Color fundus image, NIDEK AFC-230 fundus camera.
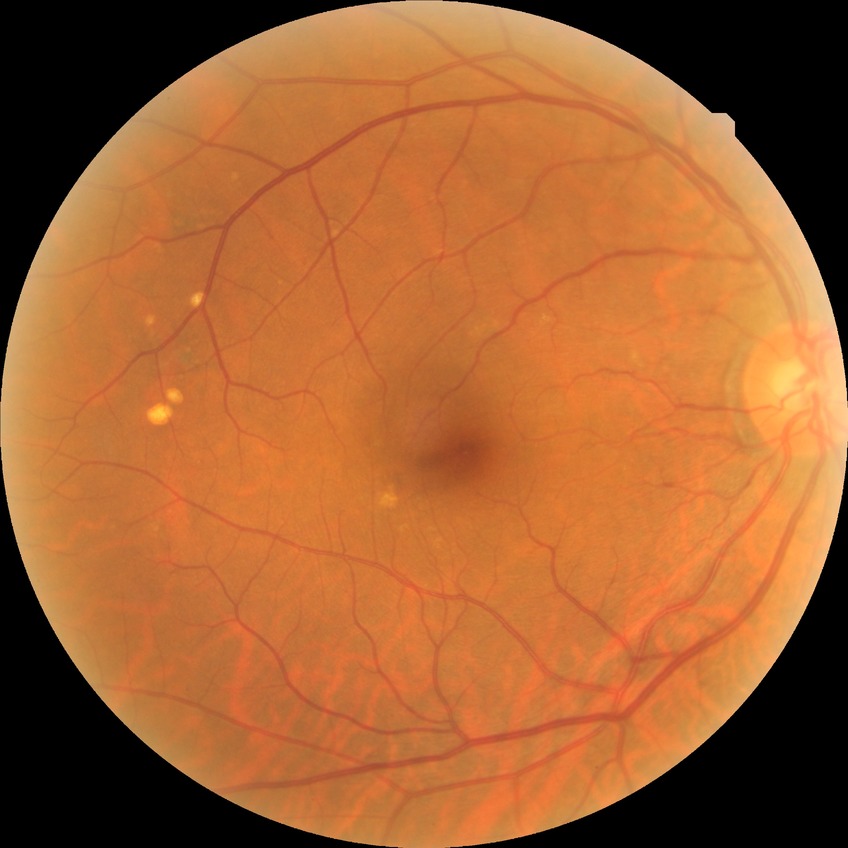
modified Davis grading@no diabetic retinopathy.